45 degree fundus photograph, nonmydriatic:
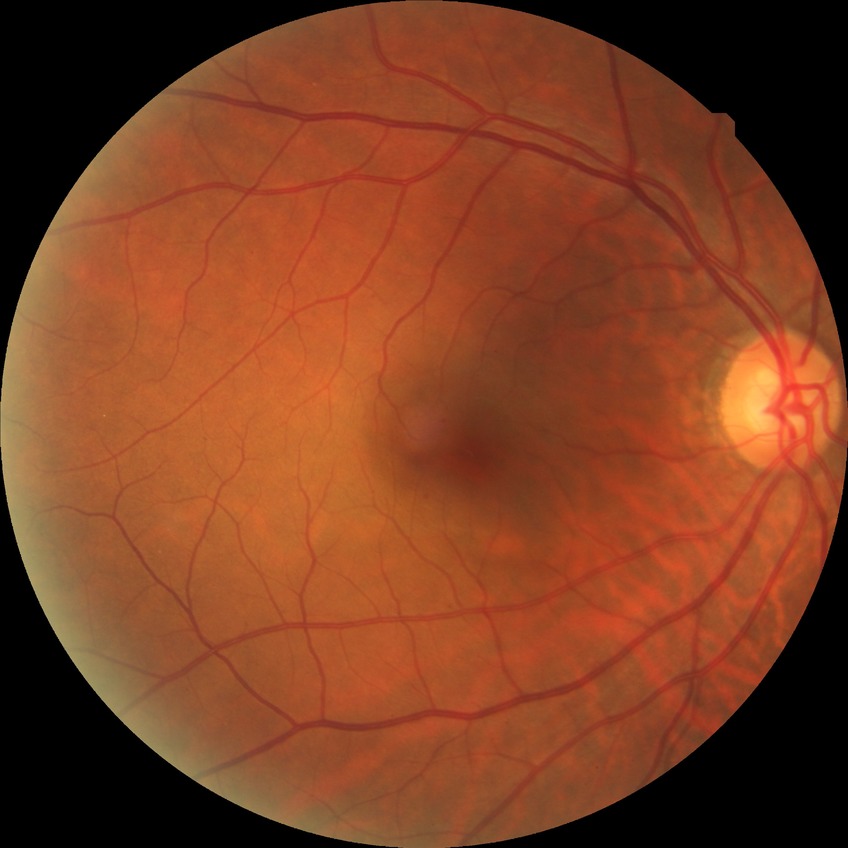
Diabetic retinopathy severity: simple diabetic retinopathy.